1932 x 1916 pixels; color fundus image — 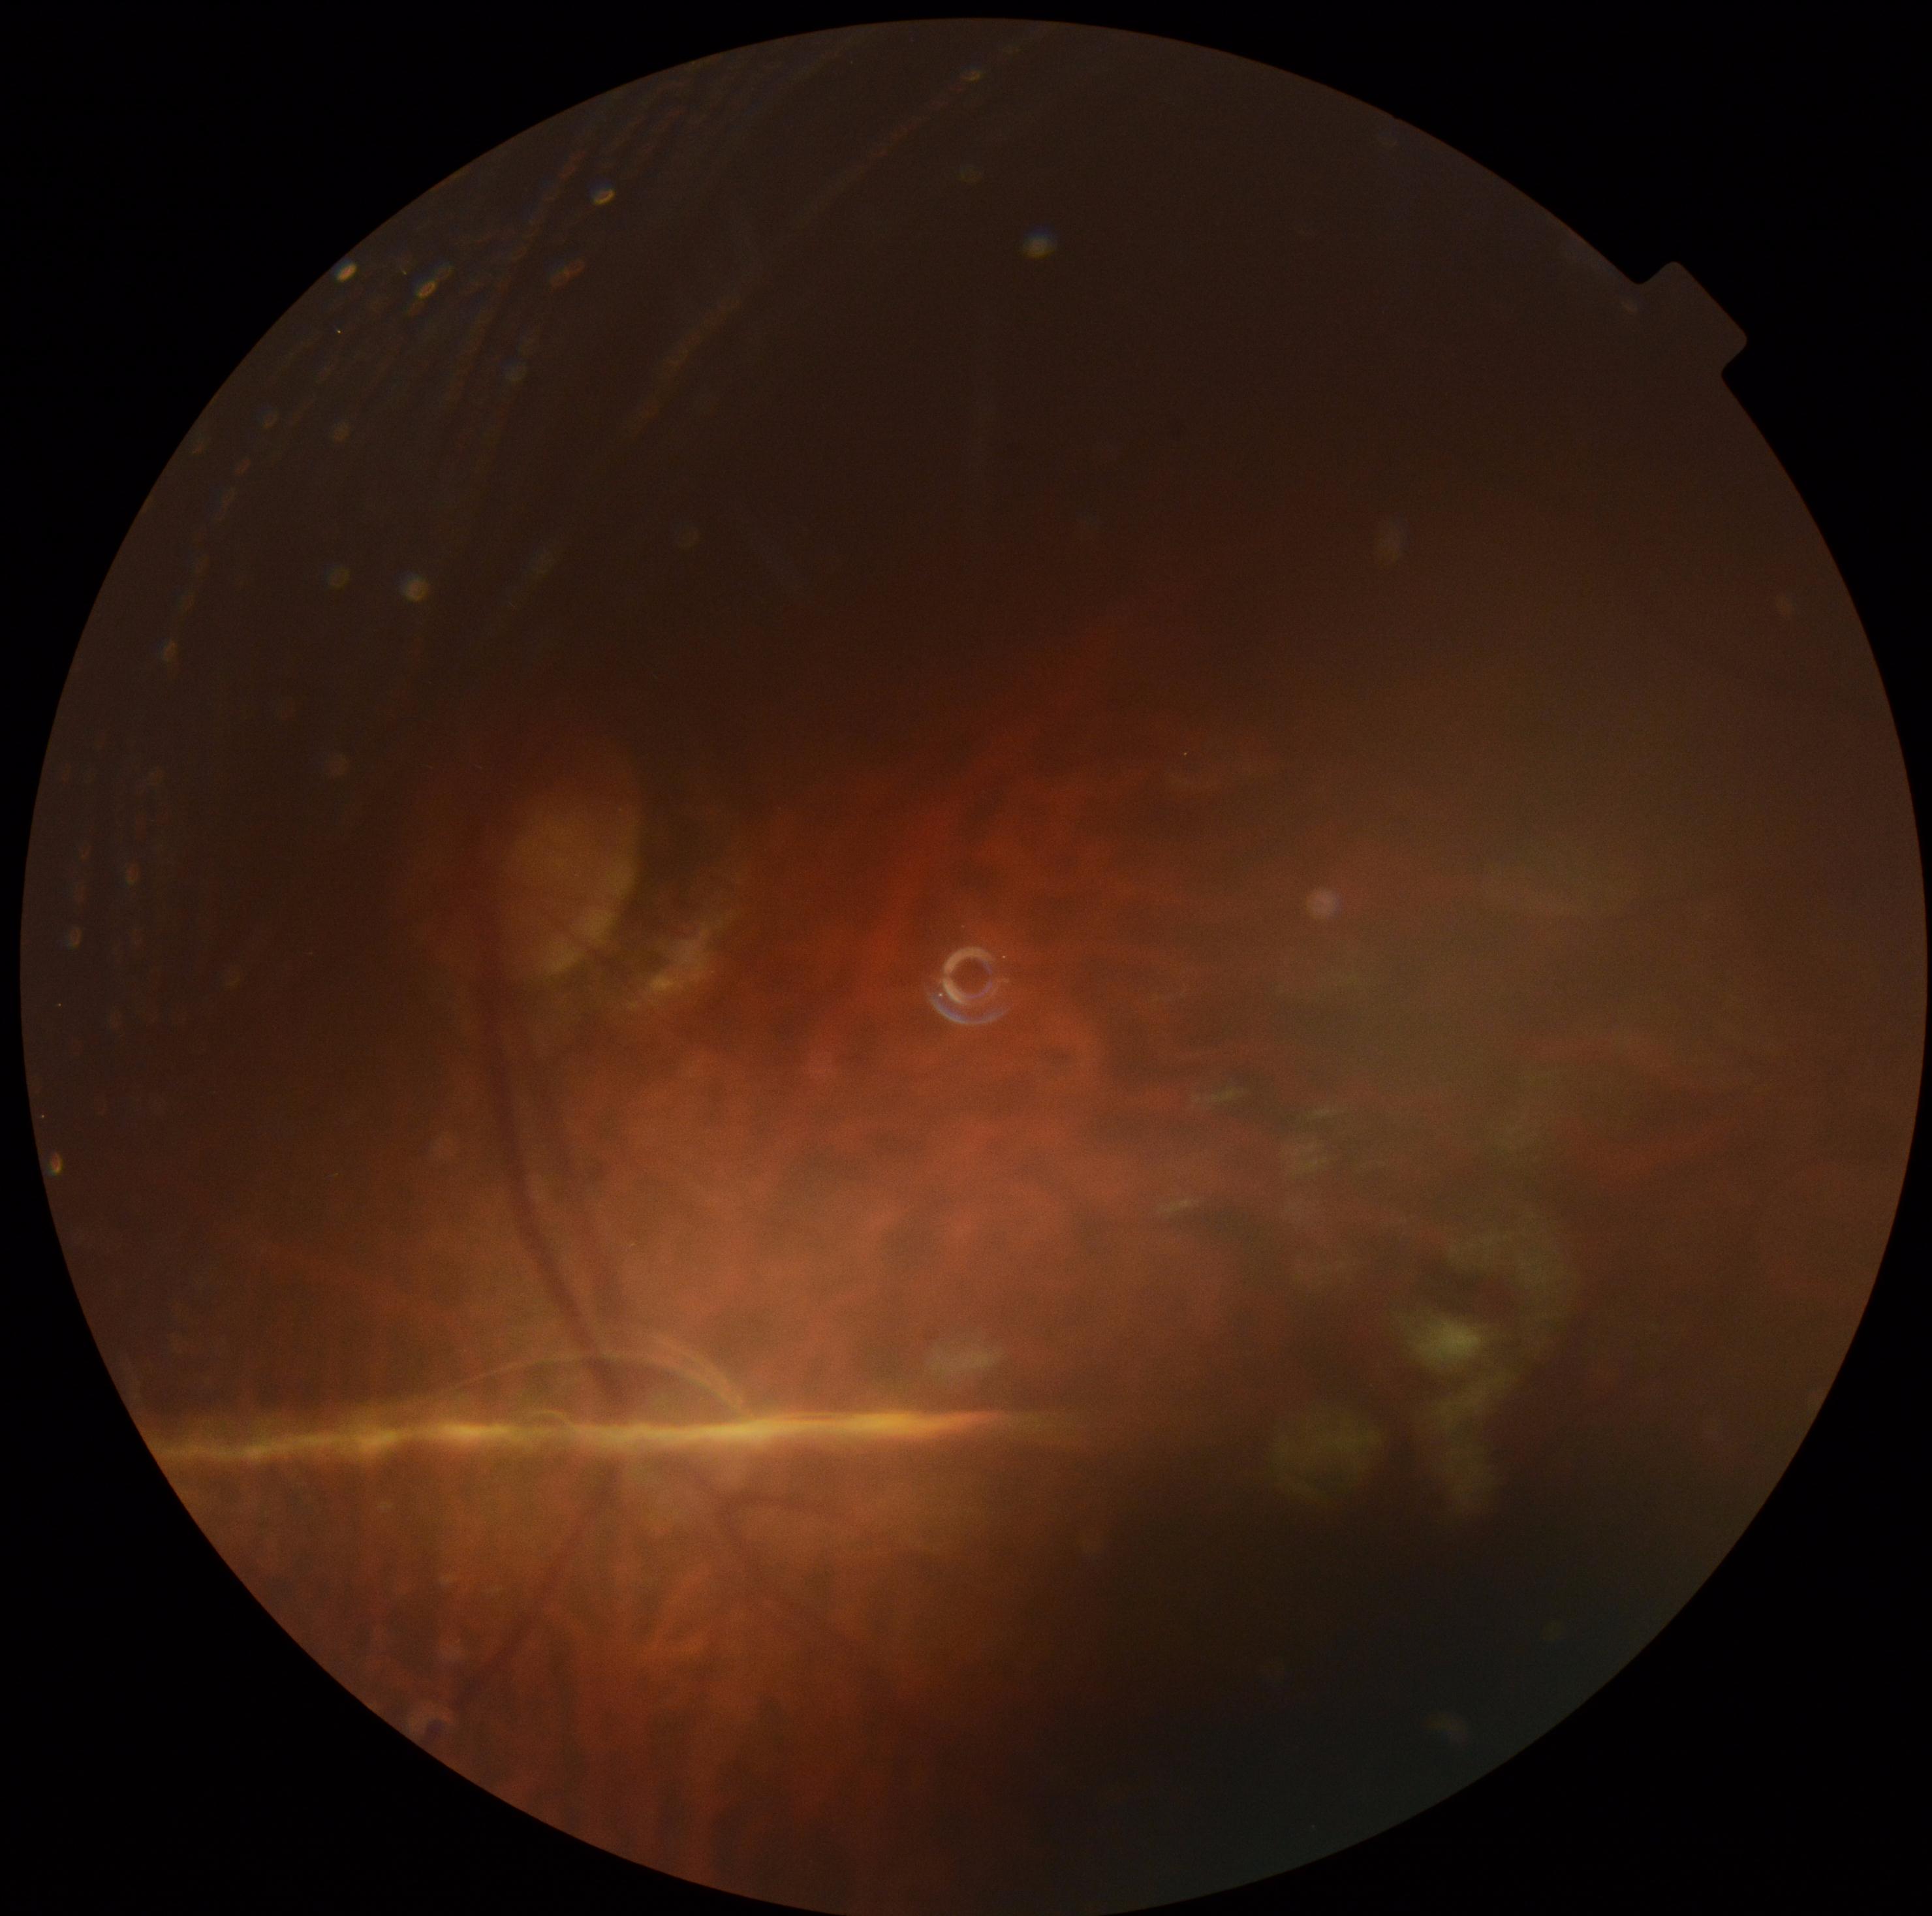

diabetic retinopathy (DR): ungradable.